FOV: 45 degrees; 2048 x 1536 pixels; fundus photo
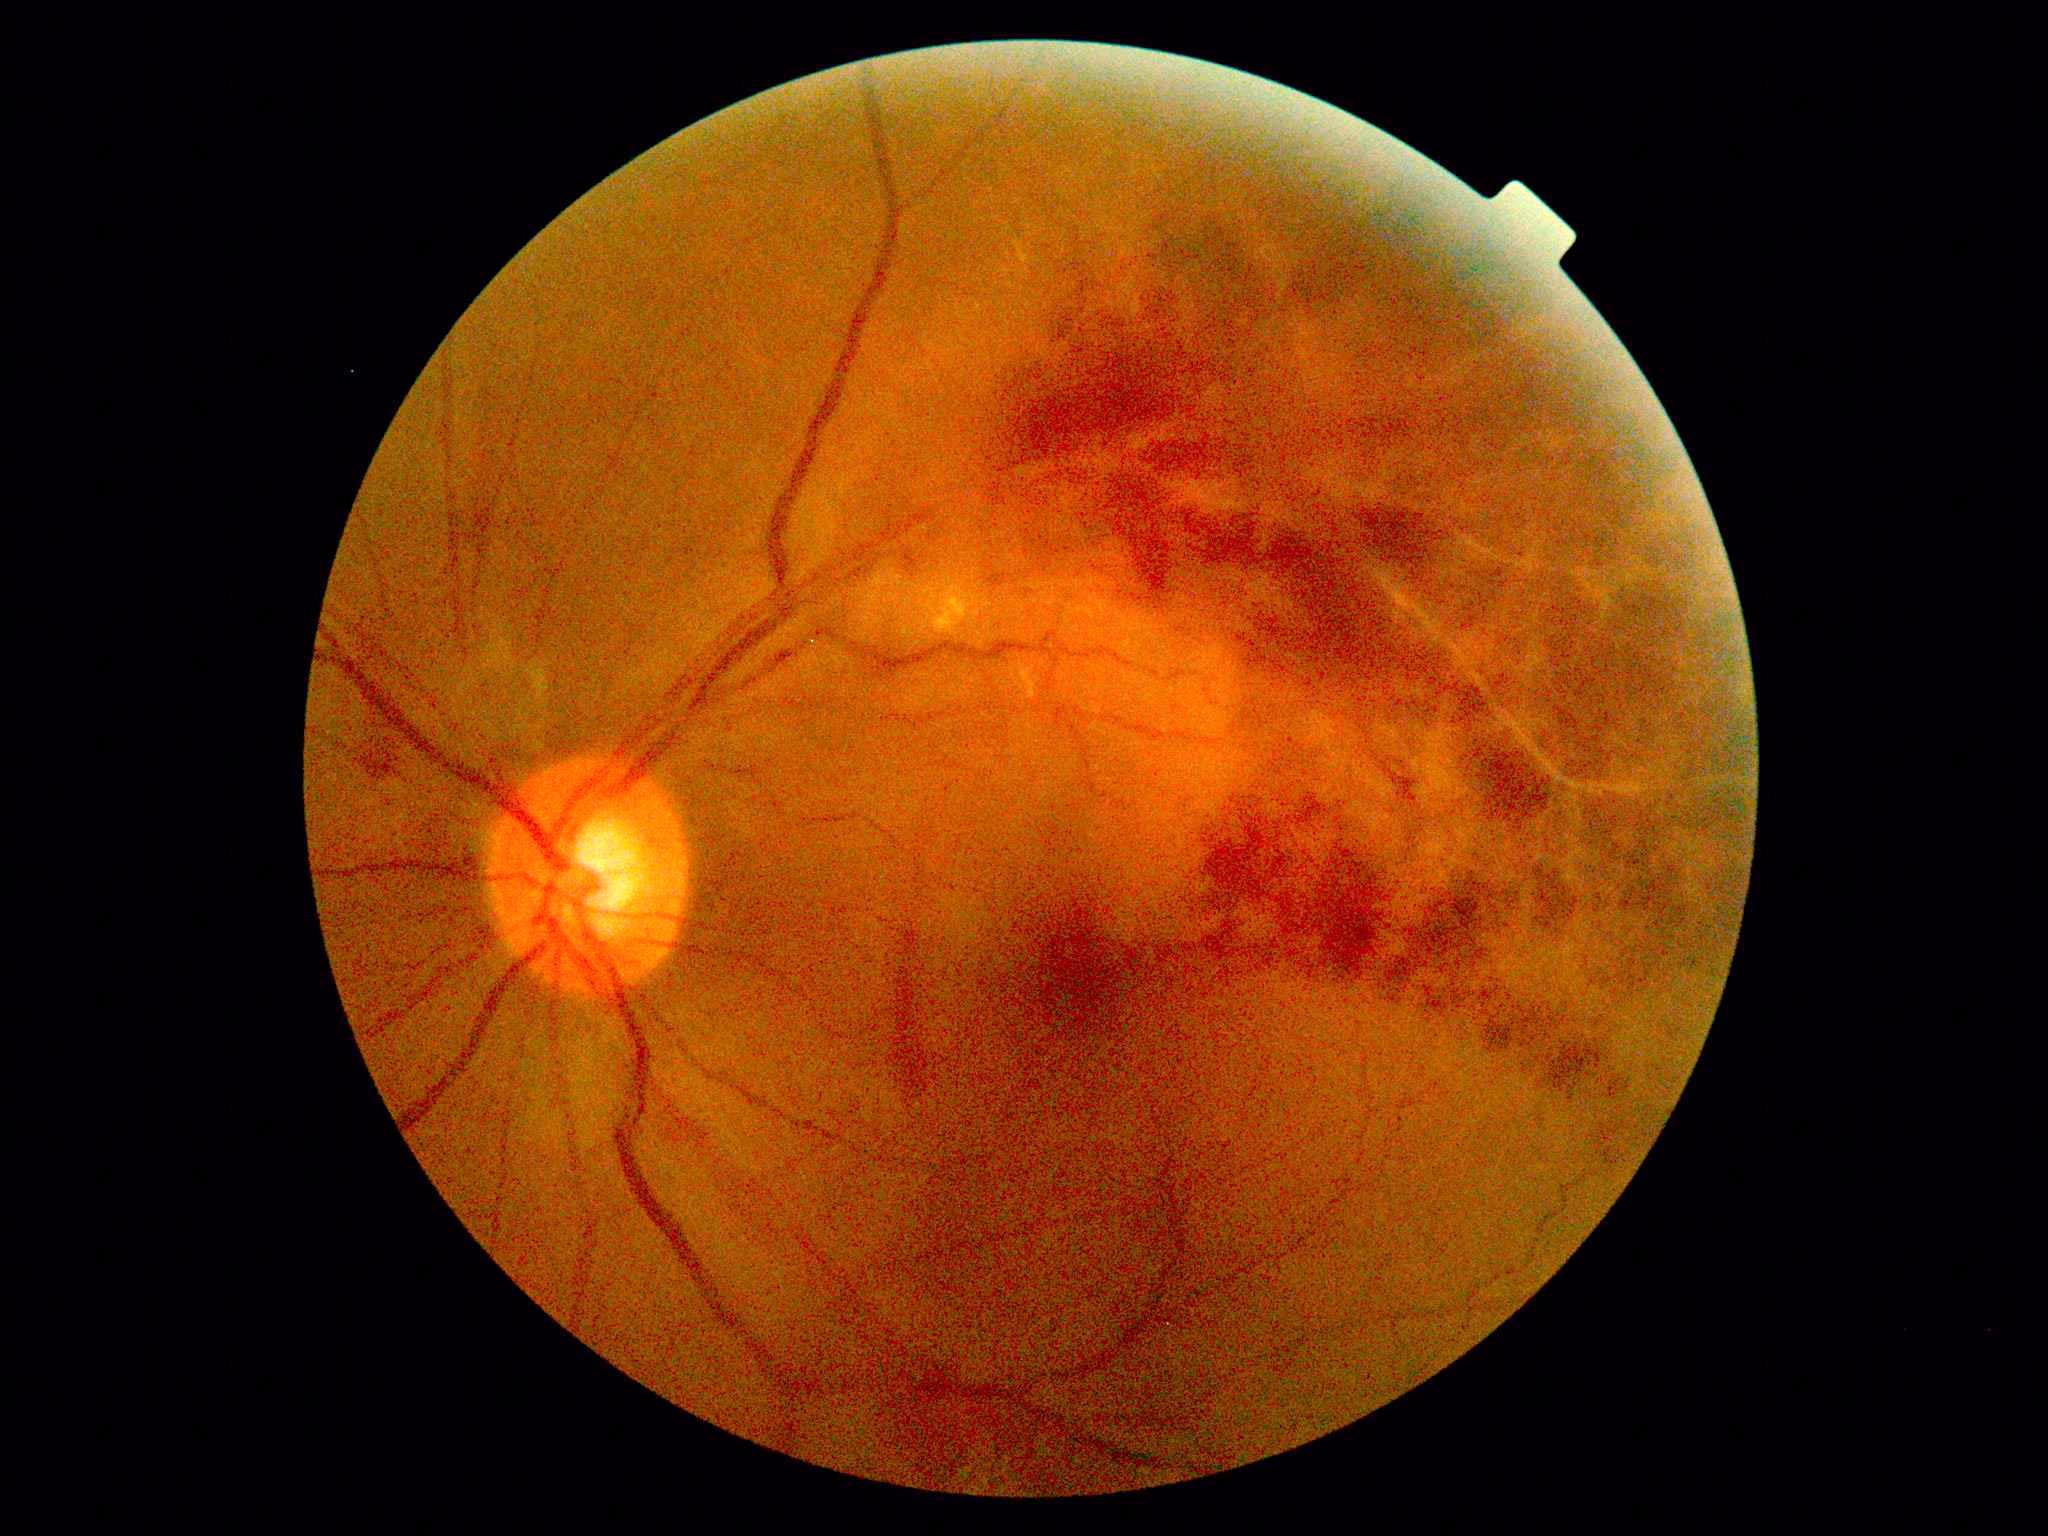 DR grade is 2 — more than just microaneurysms but less than severe NPDR.